Camera: NIDEK AFC-230, CFP, image size 848x848 — 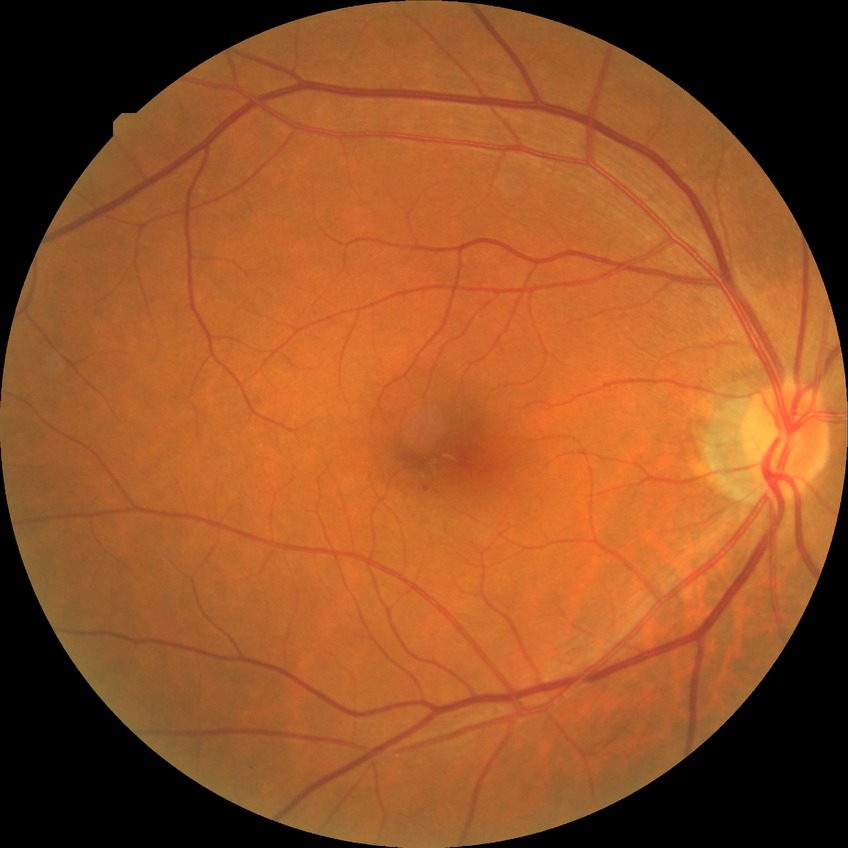

DR grade=SDR.